848 x 848 pixels:
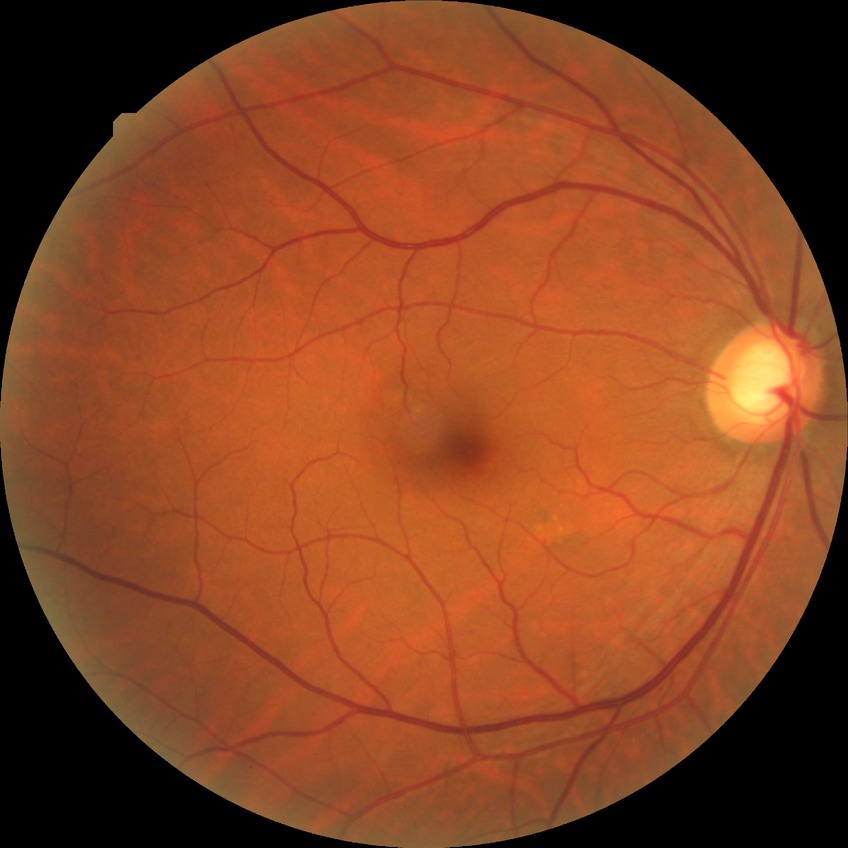

Modified Davis grade is NDR.